Infant wide-field fundus photograph; 1240x1240px; captured with the Phoenix ICON (100° field of view).
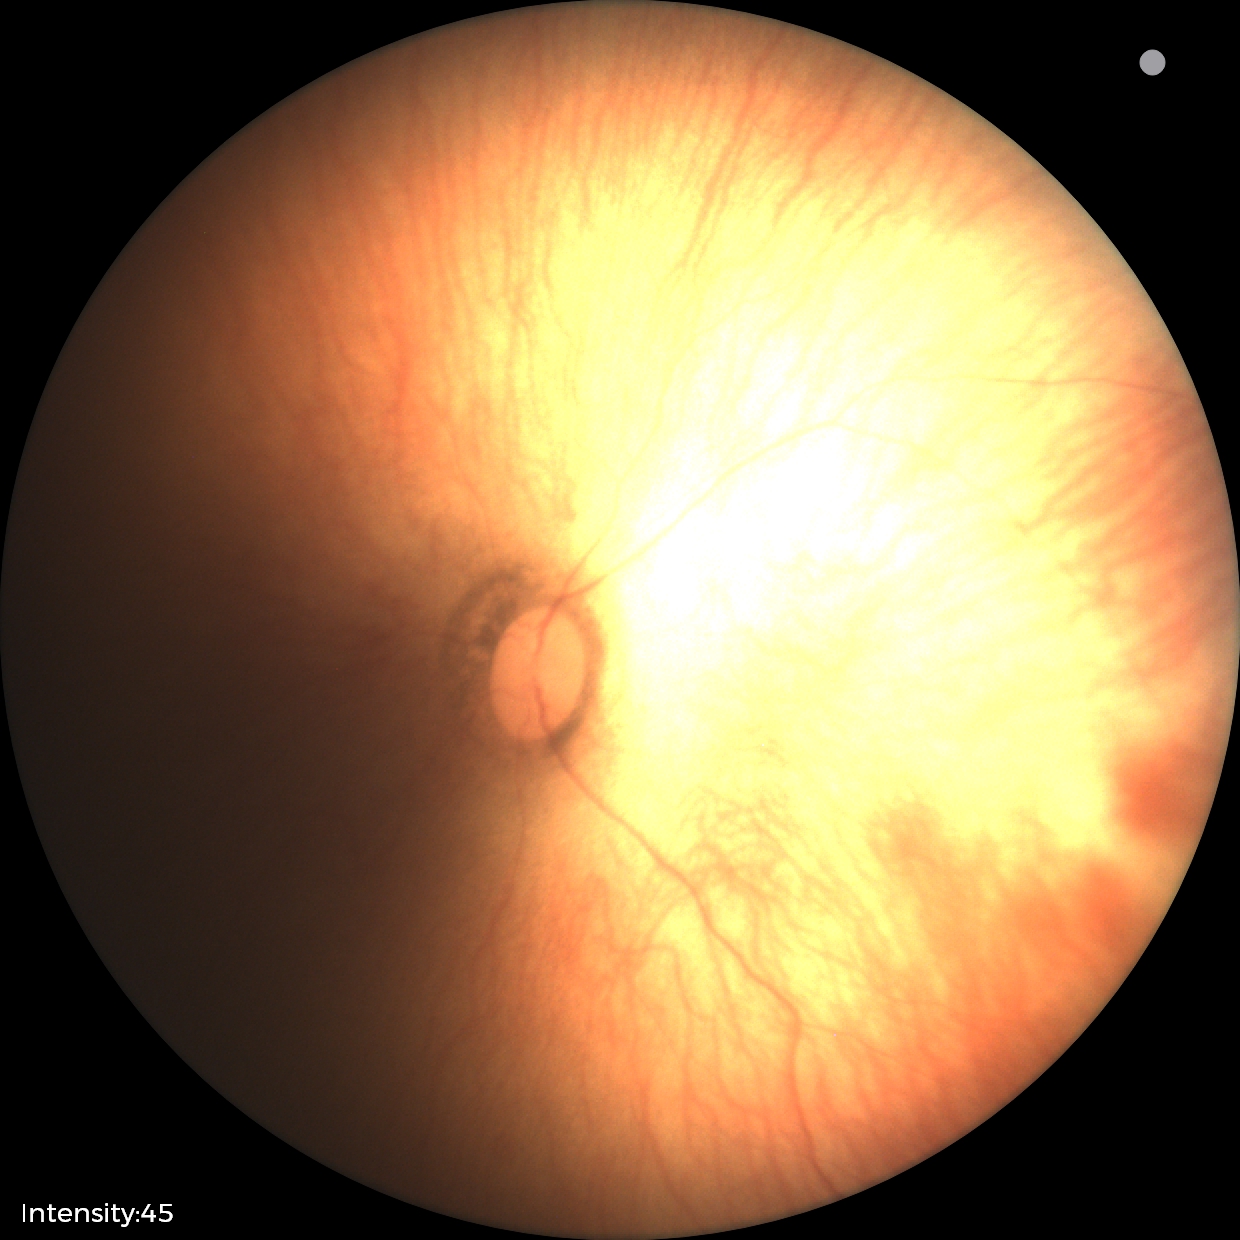

Normal screening examination.